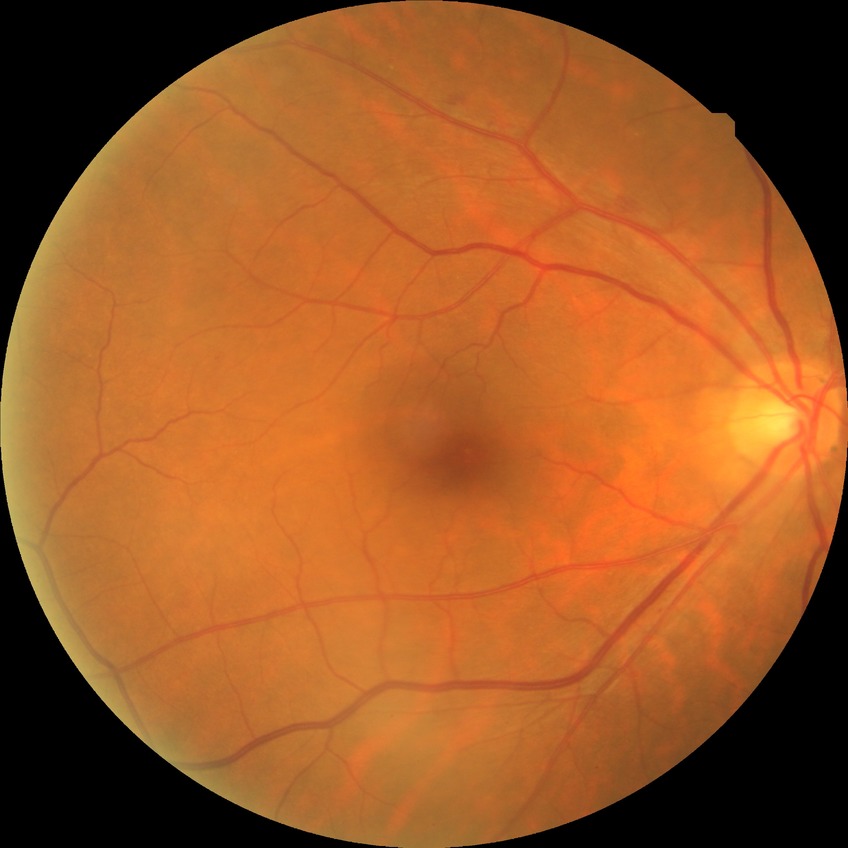

retinopathy stage = simple diabetic retinopathy
DR class = non-proliferative diabetic retinopathy